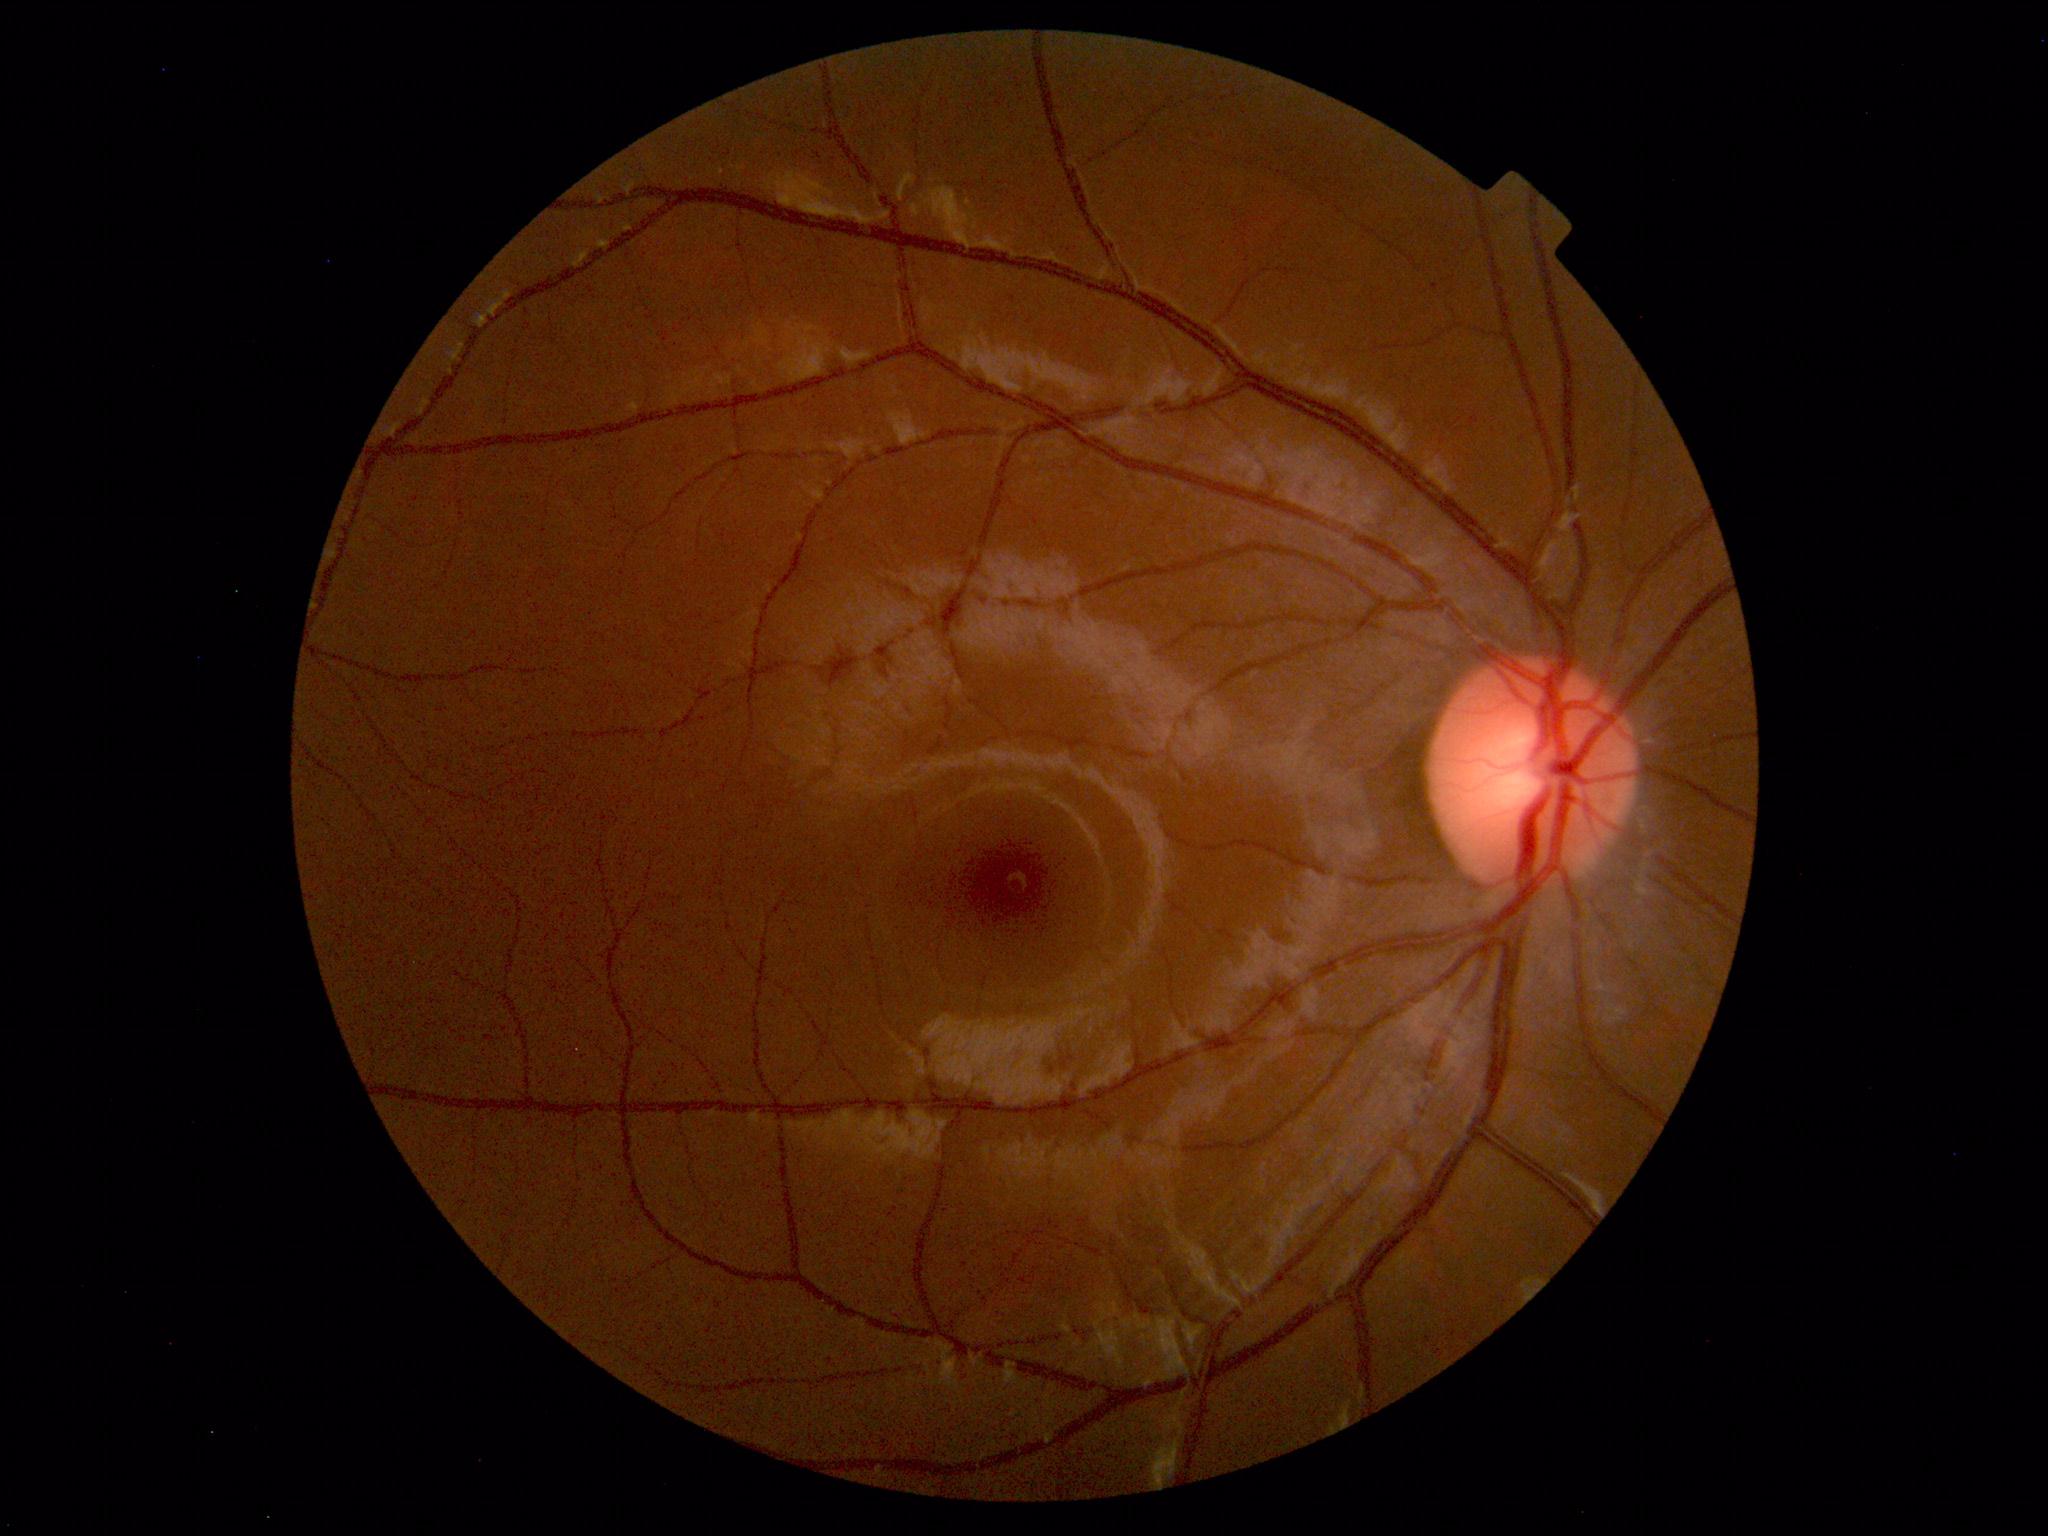 No abnormal findings on fundus examination.